45° field of view — 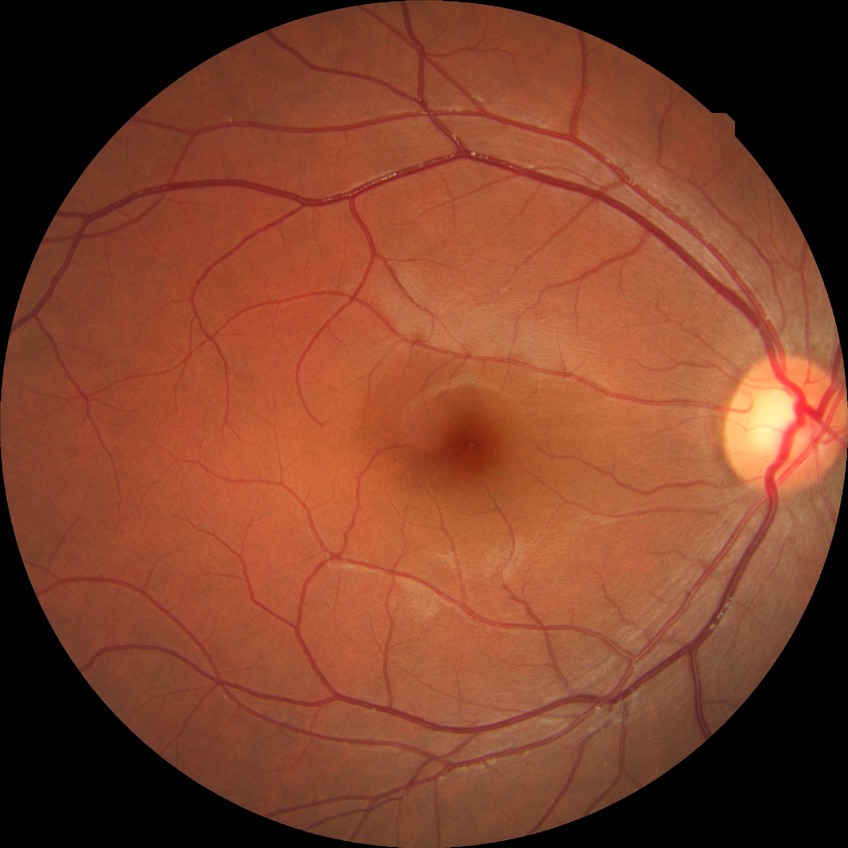
DR impression=negative for DR; Davis grade=NDR.